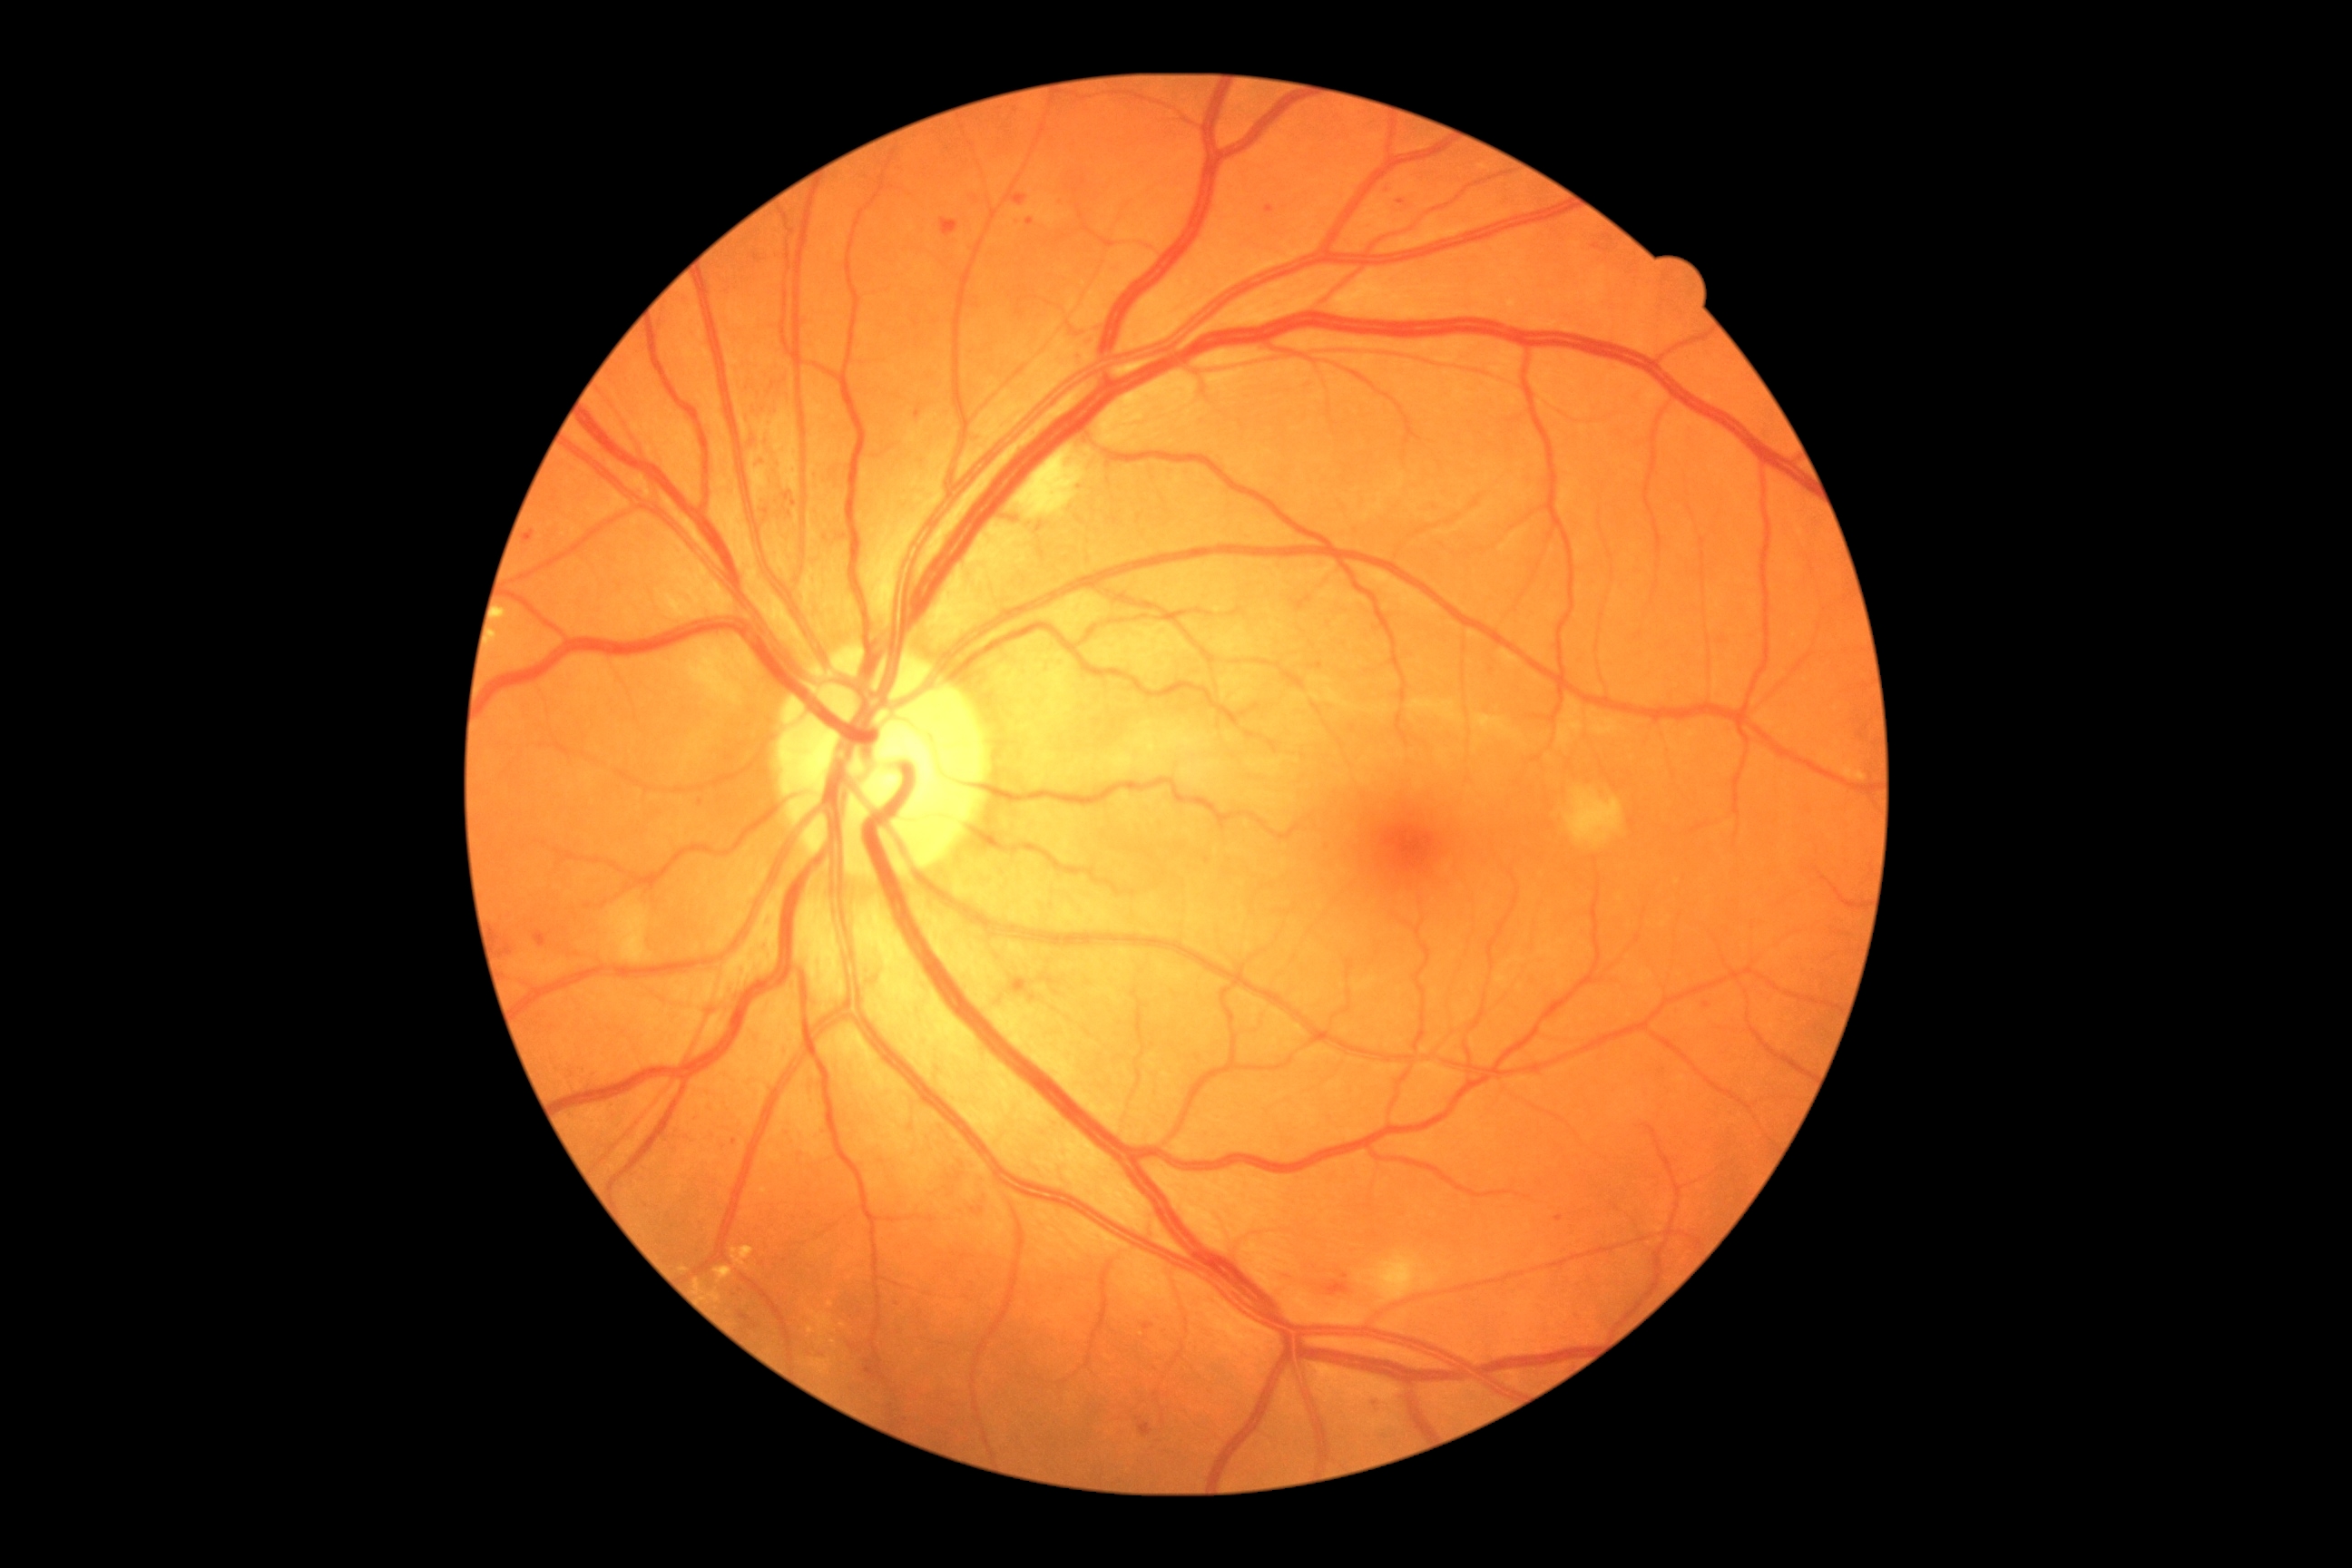
DR is grade 2 (moderate NPDR)
Selected lesions:
HEs = 495, 925, 514, 966 | 1373, 1396, 1382, 1407
SEs = 607, 899, 654, 963 | 1565, 787, 1623, 848 | 1014, 446, 1088, 520 | 1367, 1253, 1438, 1304
MAs (continued) = 914, 404, 923, 420 | 1139, 1422, 1153, 1436 | 1026, 219, 1034, 226 | 1142, 1322, 1153, 1331 | 1010, 188, 1028, 208 | 941, 219, 959, 239 | 1266, 206, 1275, 215 | 785, 491, 792, 500 | 1373, 1396, 1382, 1411 | 534, 932, 545, 948 | 524, 531, 536, 545 | 1326, 1280, 1351, 1297
Small MAs approximately at {"x": 1401, "y": 202} | {"x": 1559, "y": 1218} | {"x": 1345, "y": 1276} | {"x": 767, "y": 511} | {"x": 735, "y": 1143} | {"x": 1706, "y": 1005} | {"x": 795, "y": 504}
EXs = 694, 1279, 701, 1293 | 680, 1266, 689, 1273 | 500, 611, 507, 620 | 732, 1246, 754, 1268 | 709, 1291, 720, 1302 | 714, 1266, 732, 1282